45° FOV, 2352x1568px — 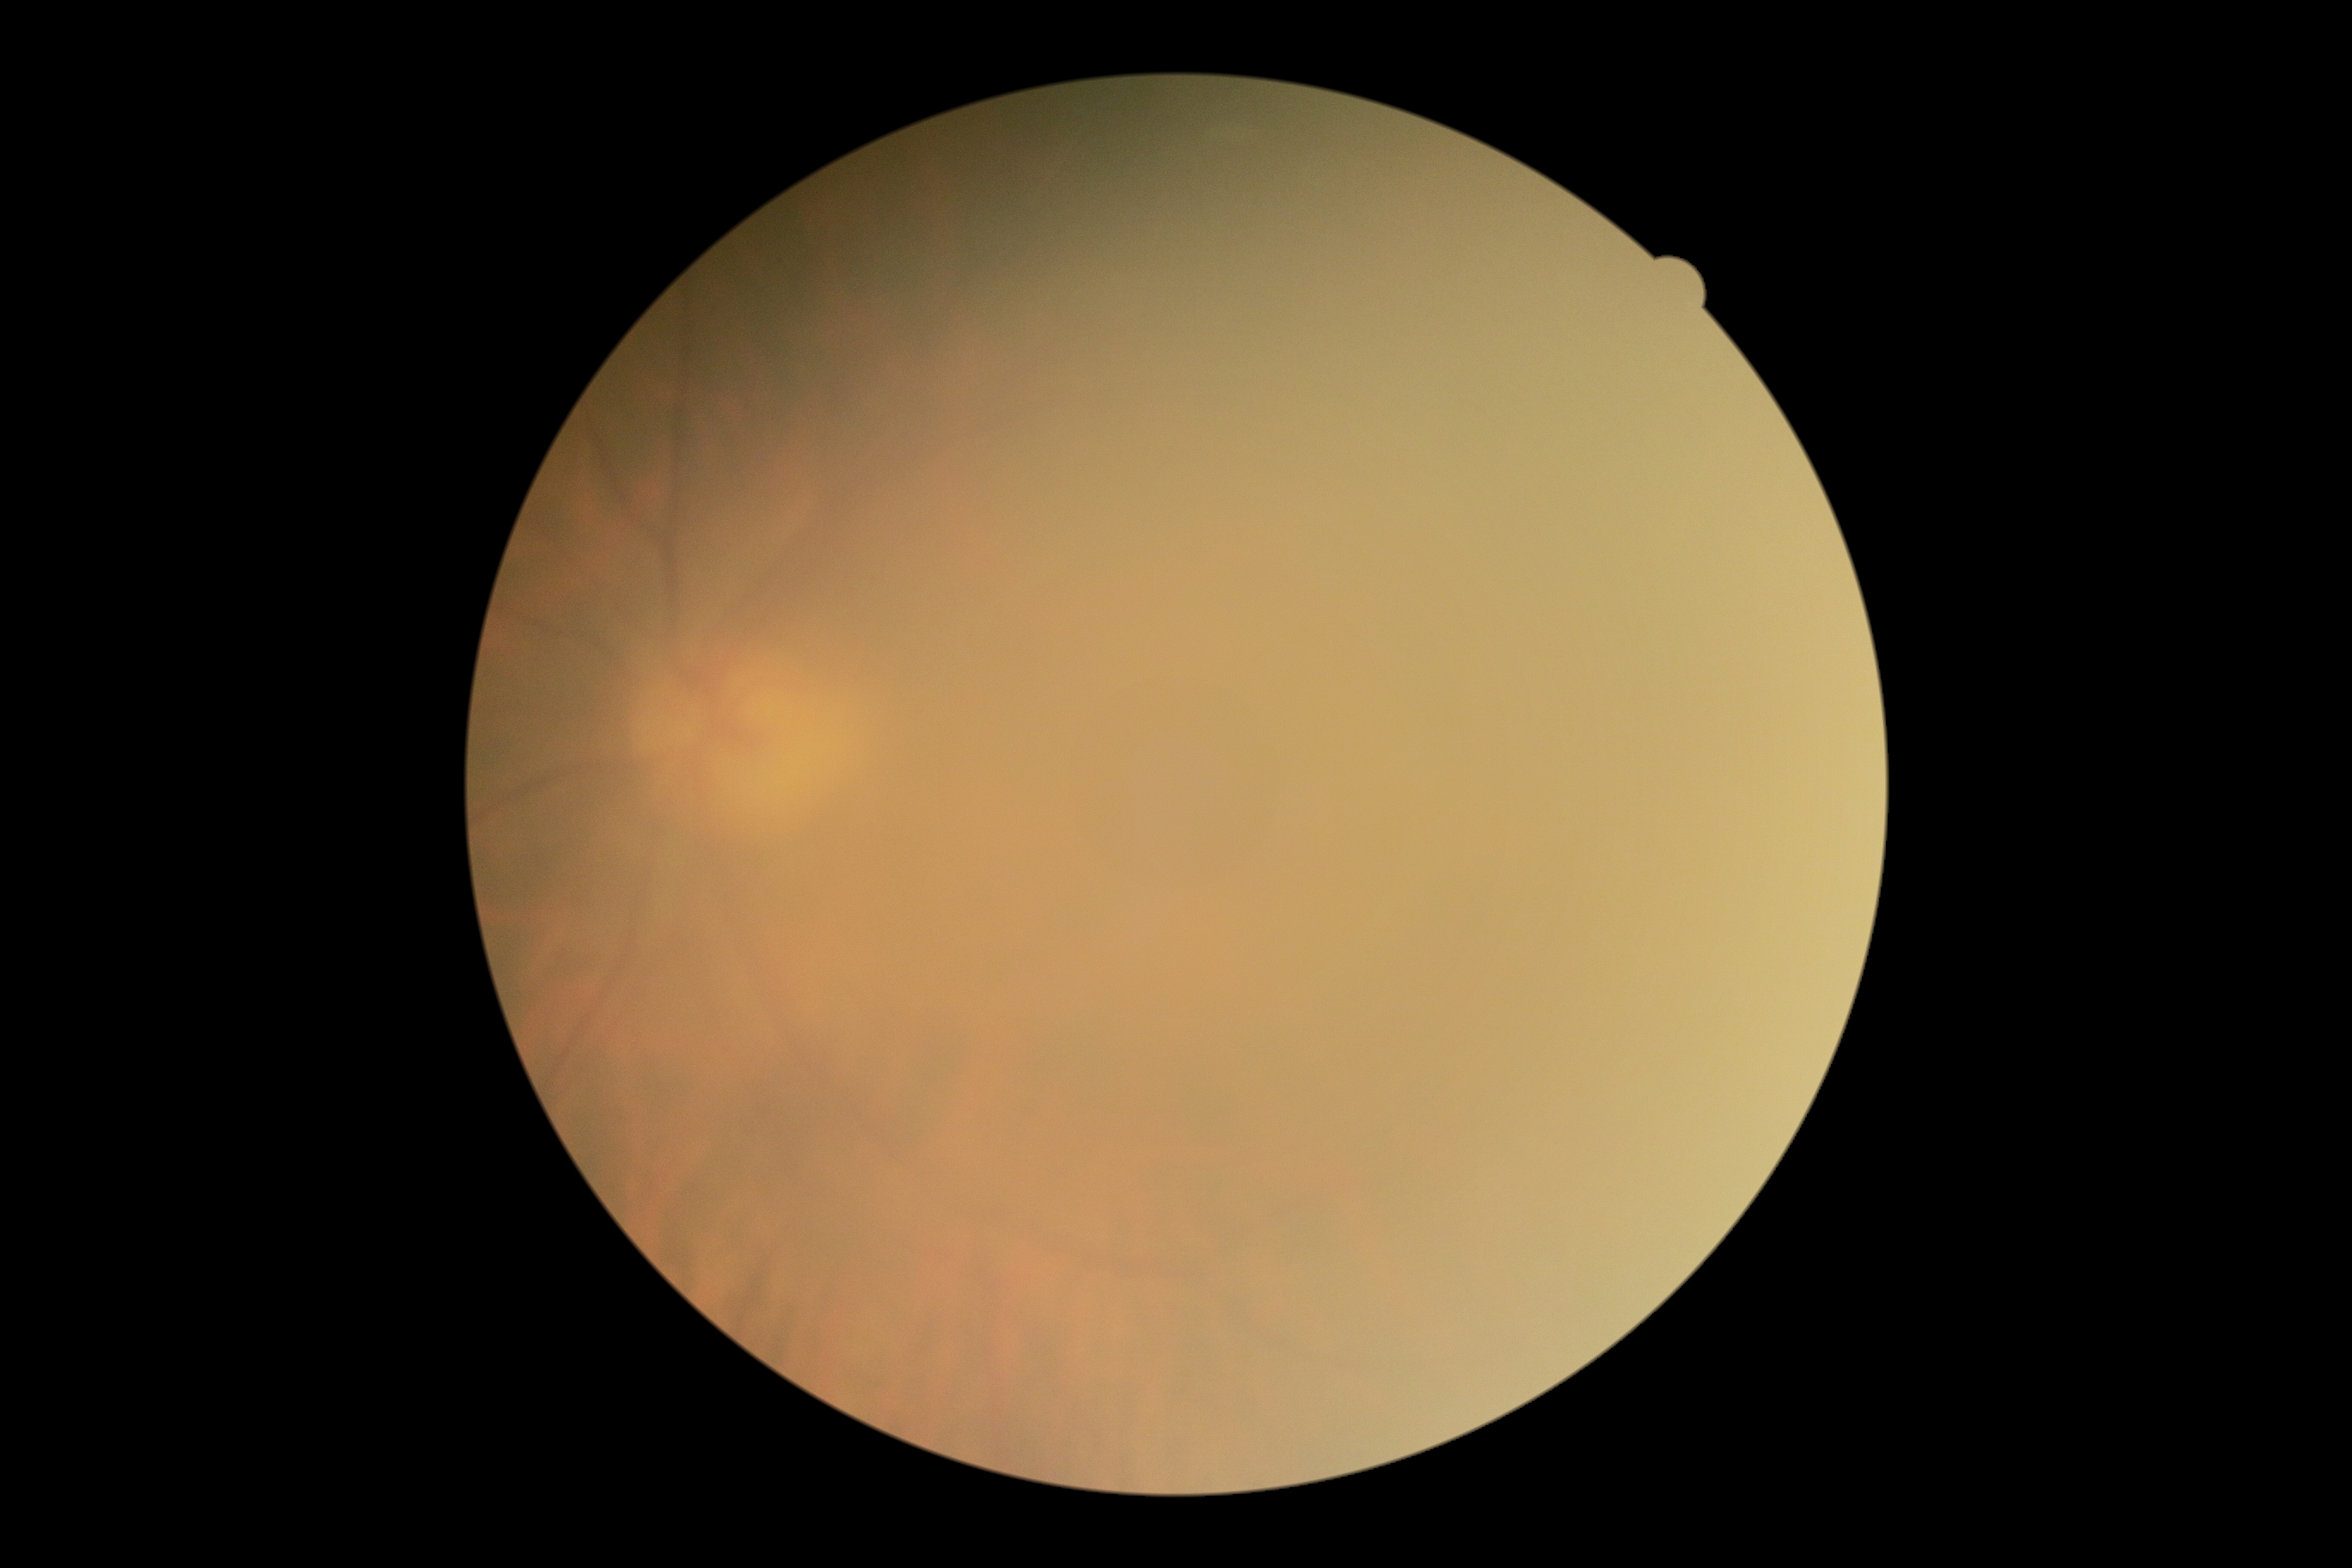

diabetic retinopathy: ungradable due to poor image quality.